848 by 848 pixels; 45-degree field of view.
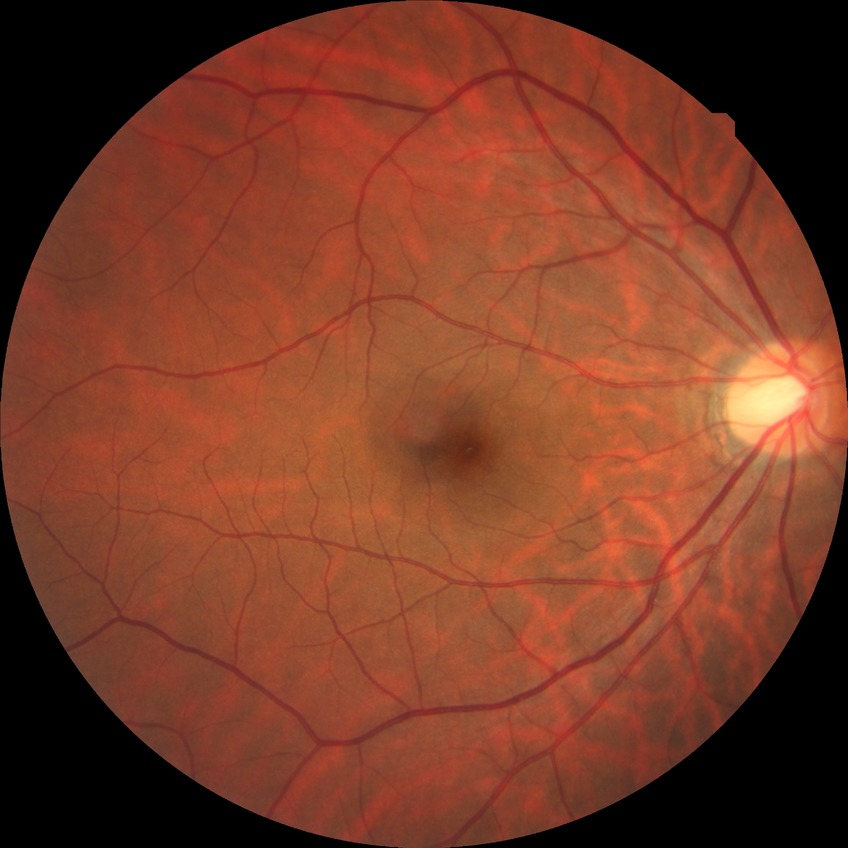 Diabetic retinopathy (DR) is no diabetic retinopathy (NDR).